45° field of view:
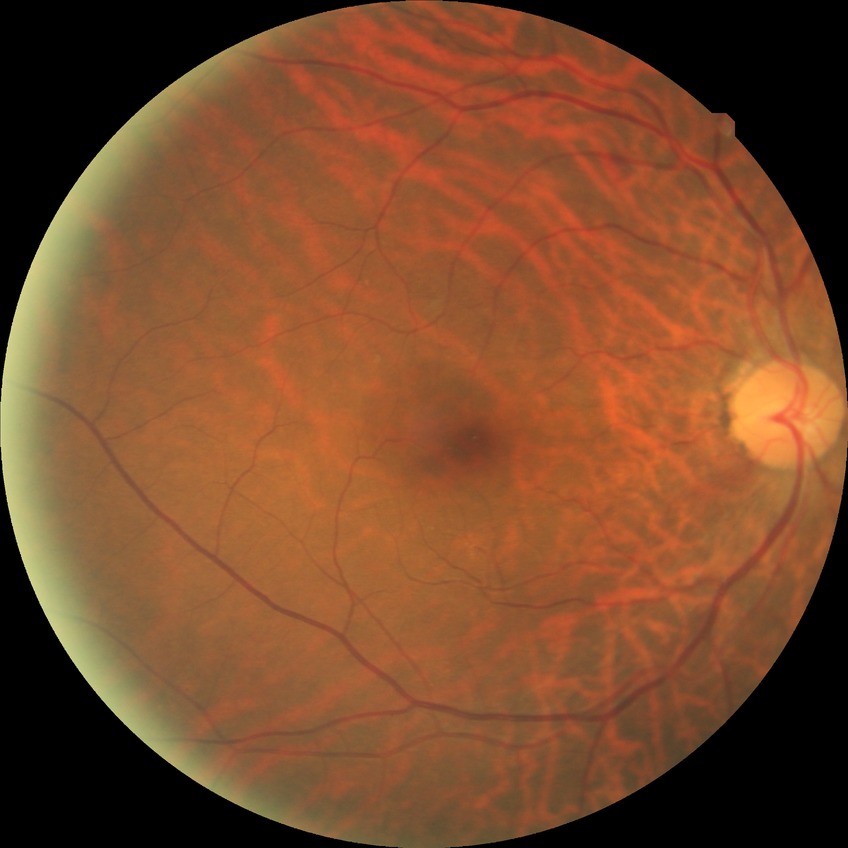
Davis grading is no diabetic retinopathy.